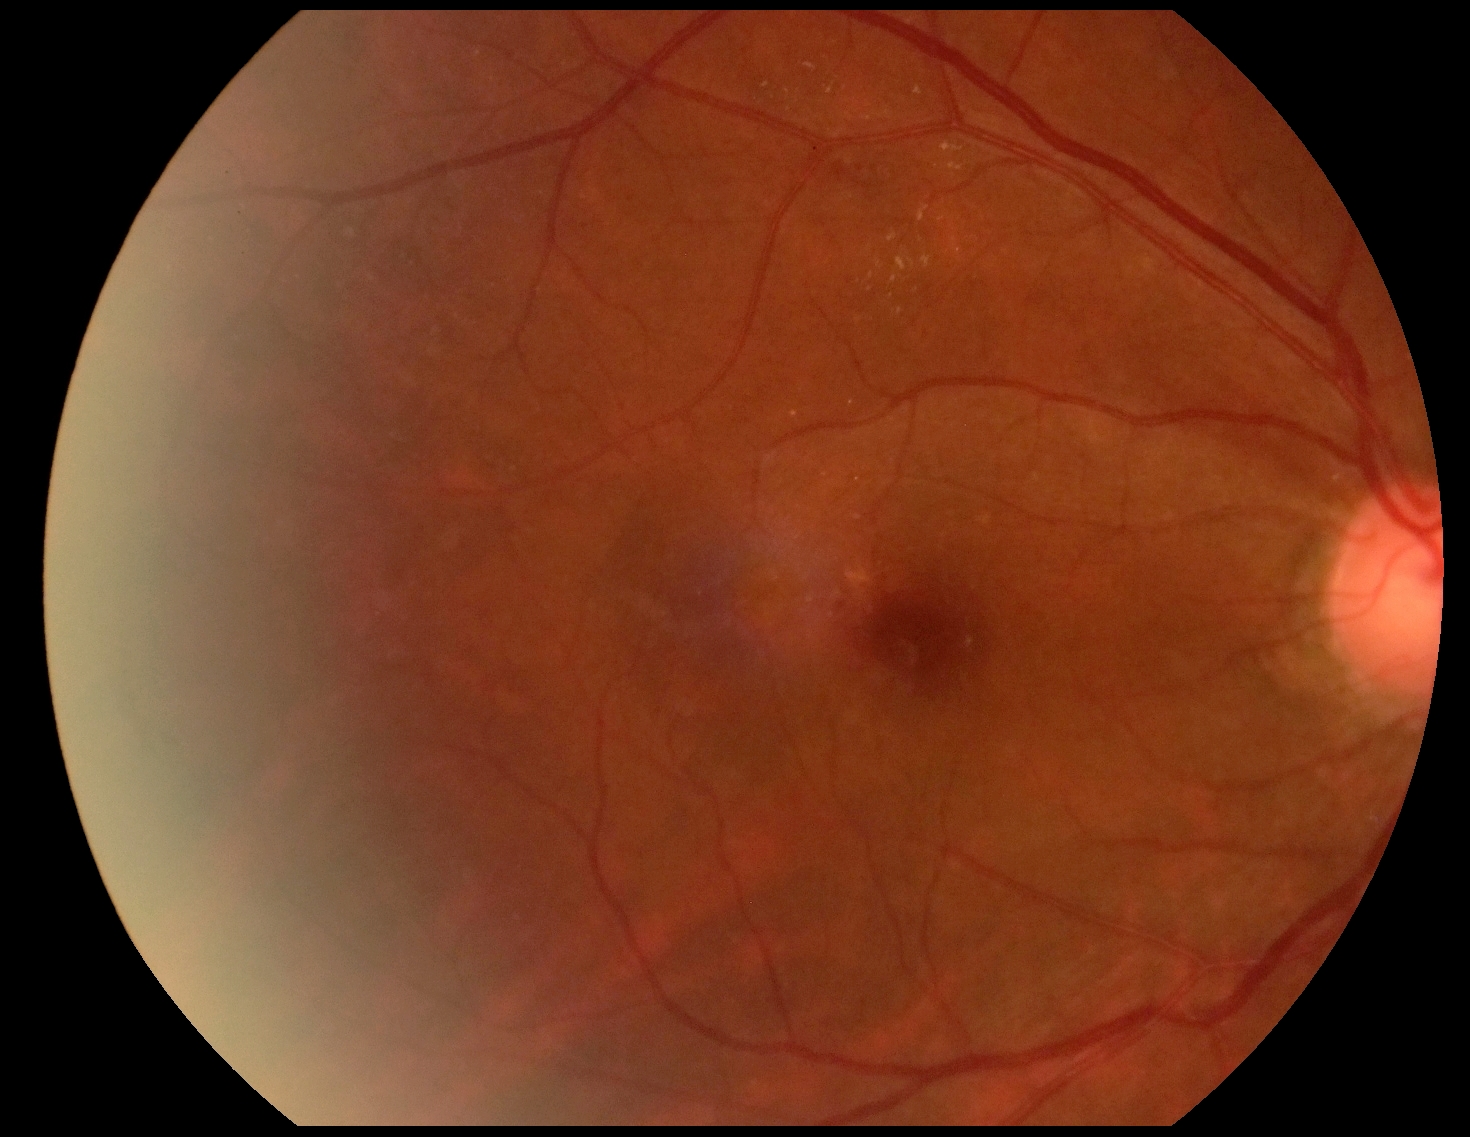 diabetic retinopathy (DR): grade 2 (moderate NPDR).